Infant wide-field fundus photograph
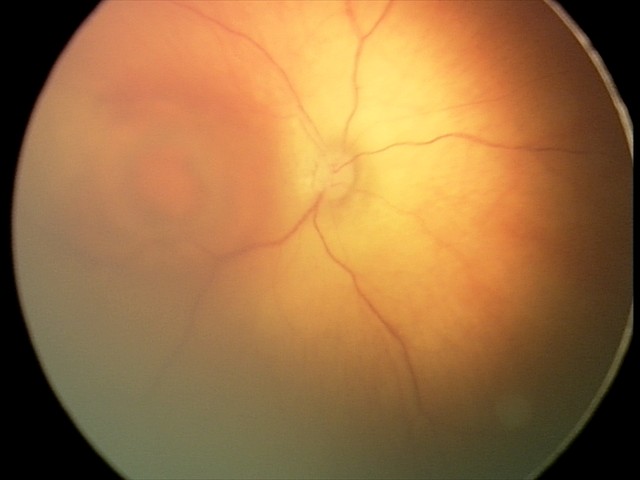 Assessment: toxoplasmosis chorioretinitis